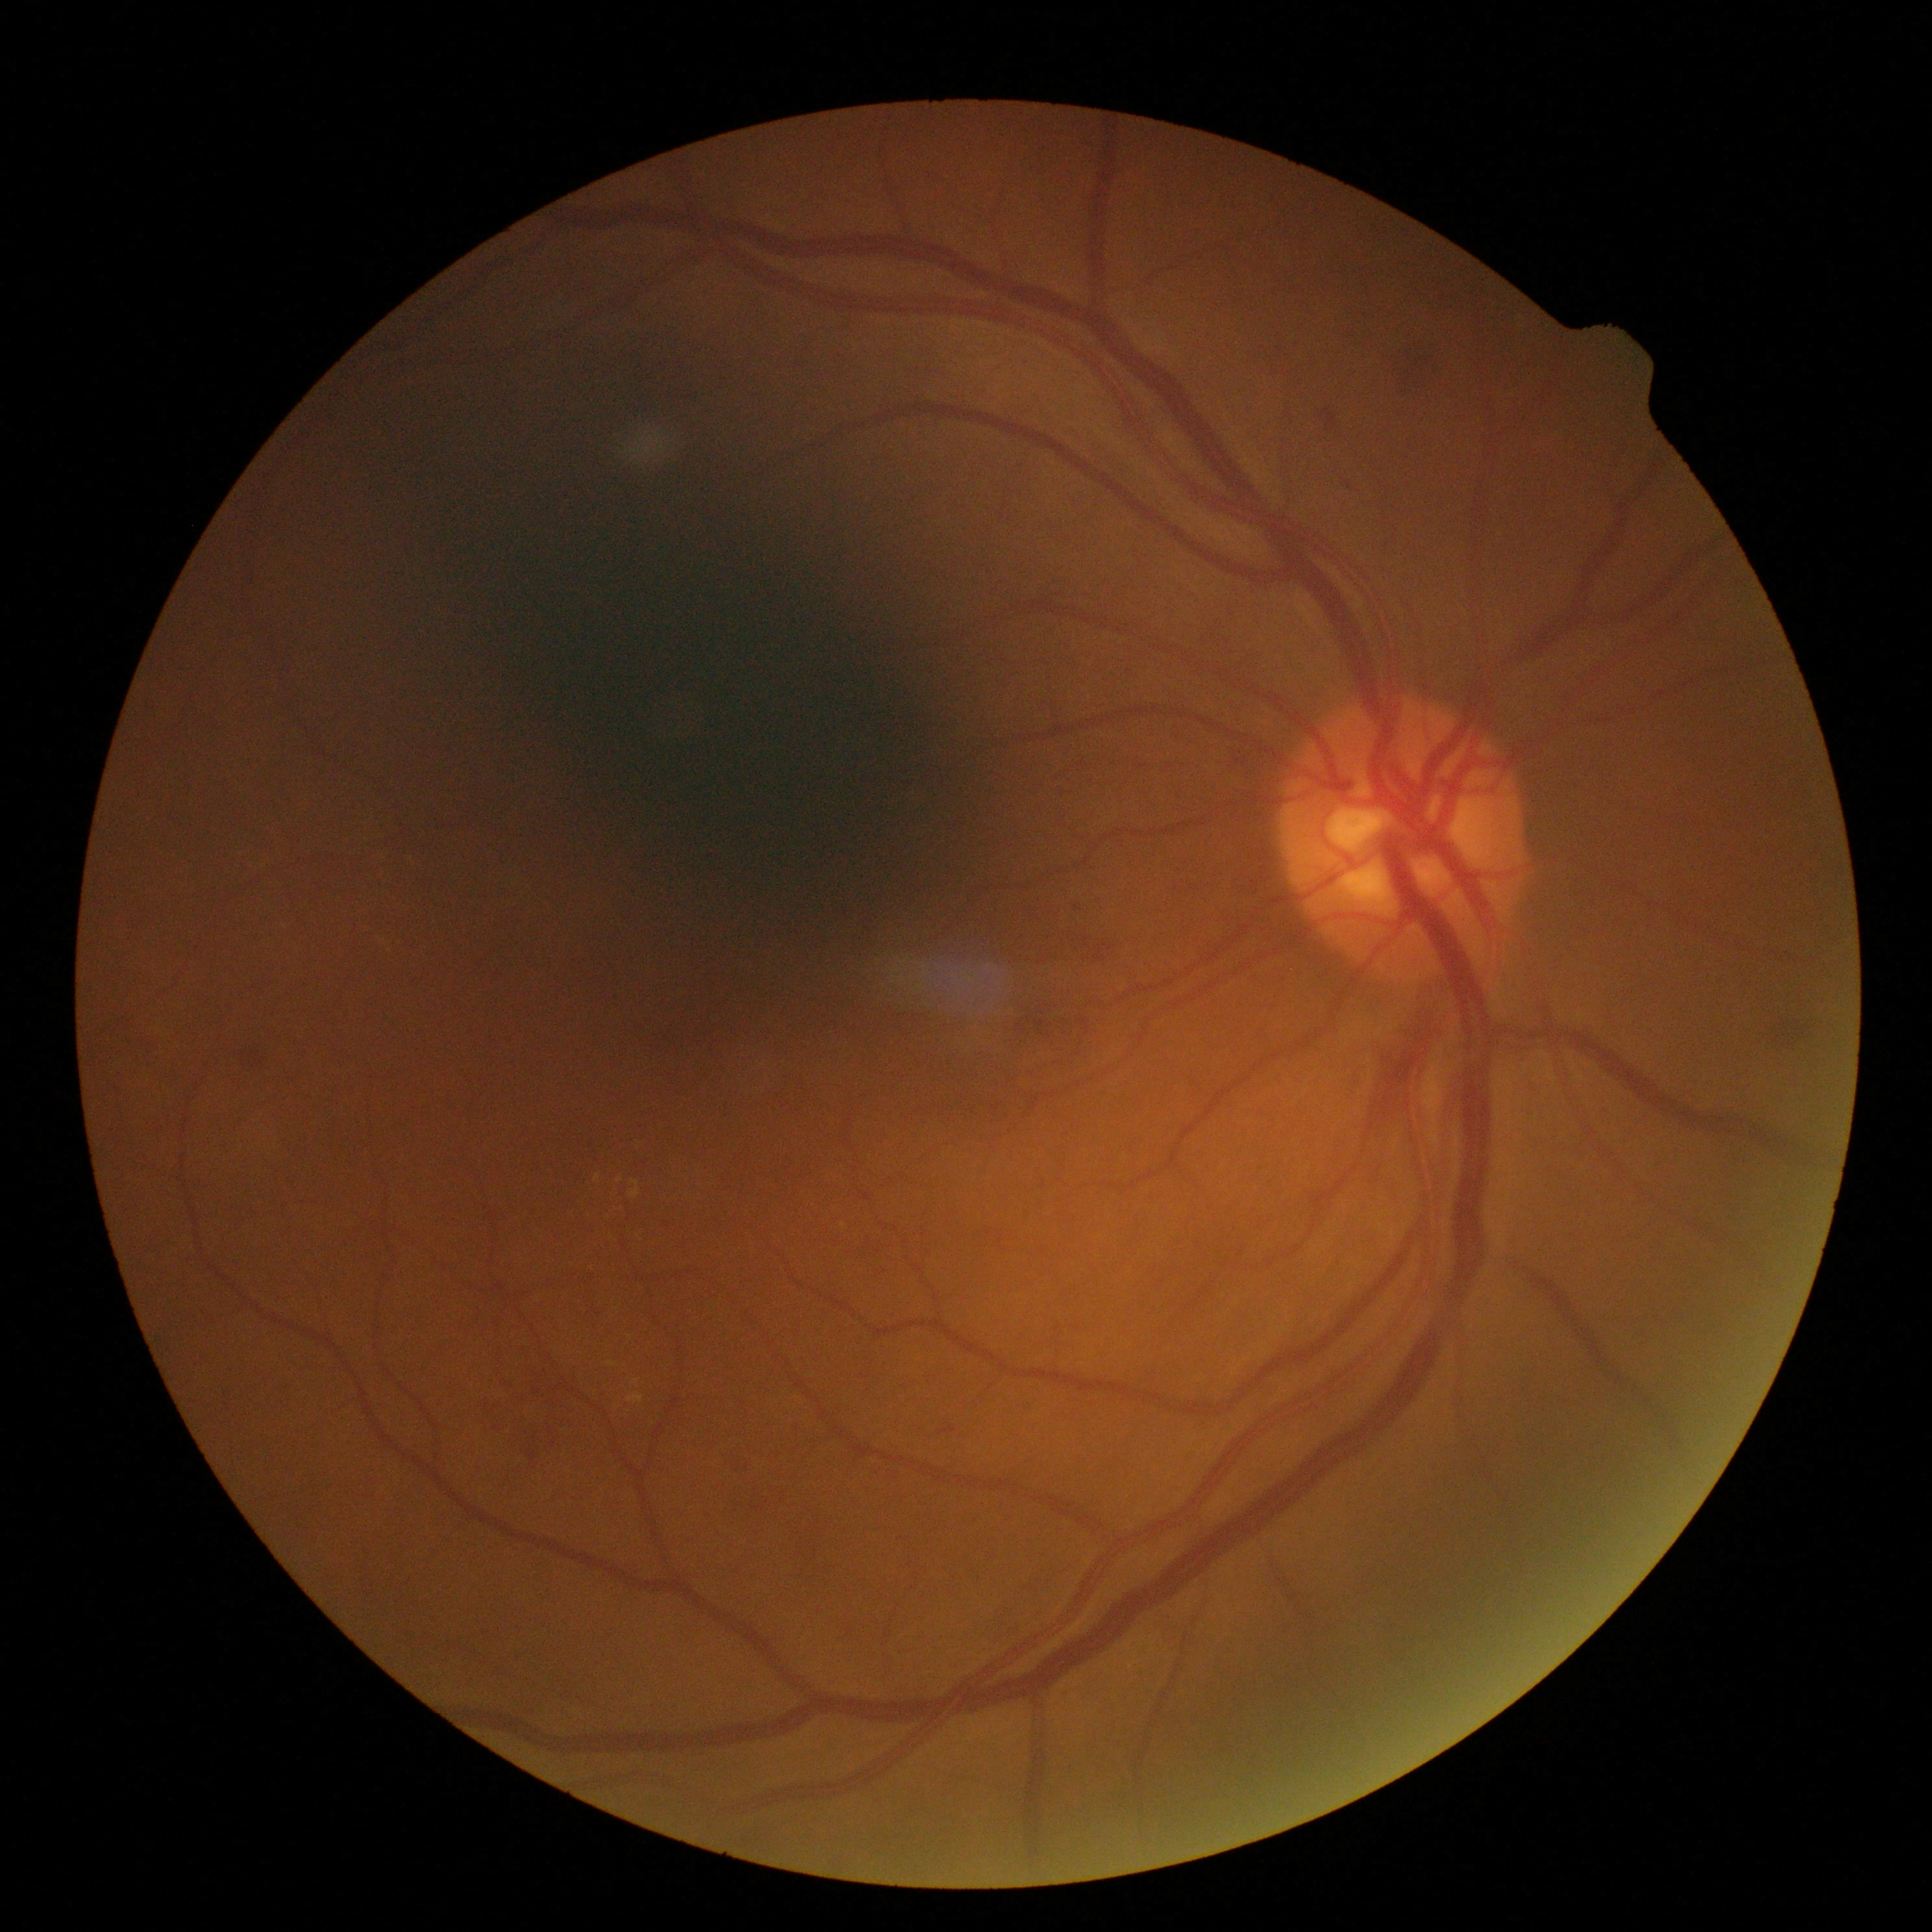 DR severity: grade 2.